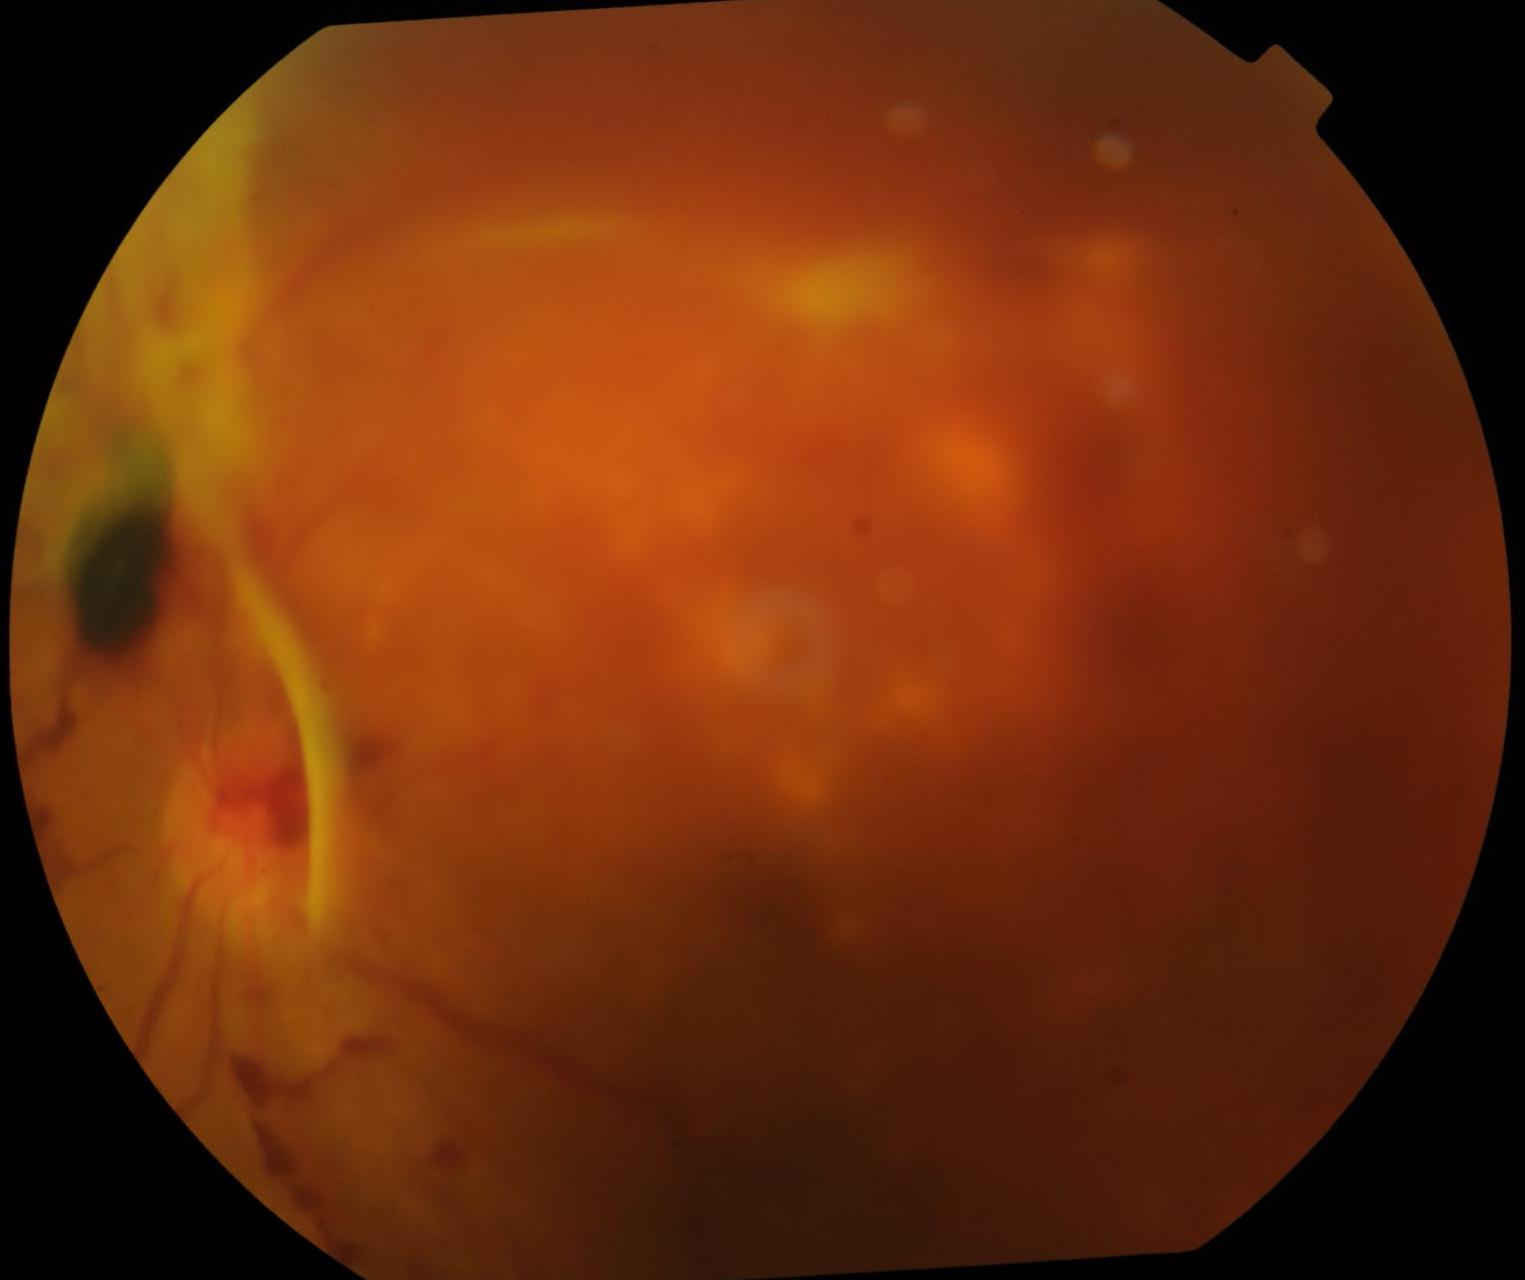
Findings:
* diabetic retinopathy (DR) — PDR (grade 4)